1536x1152px; fundus photo: 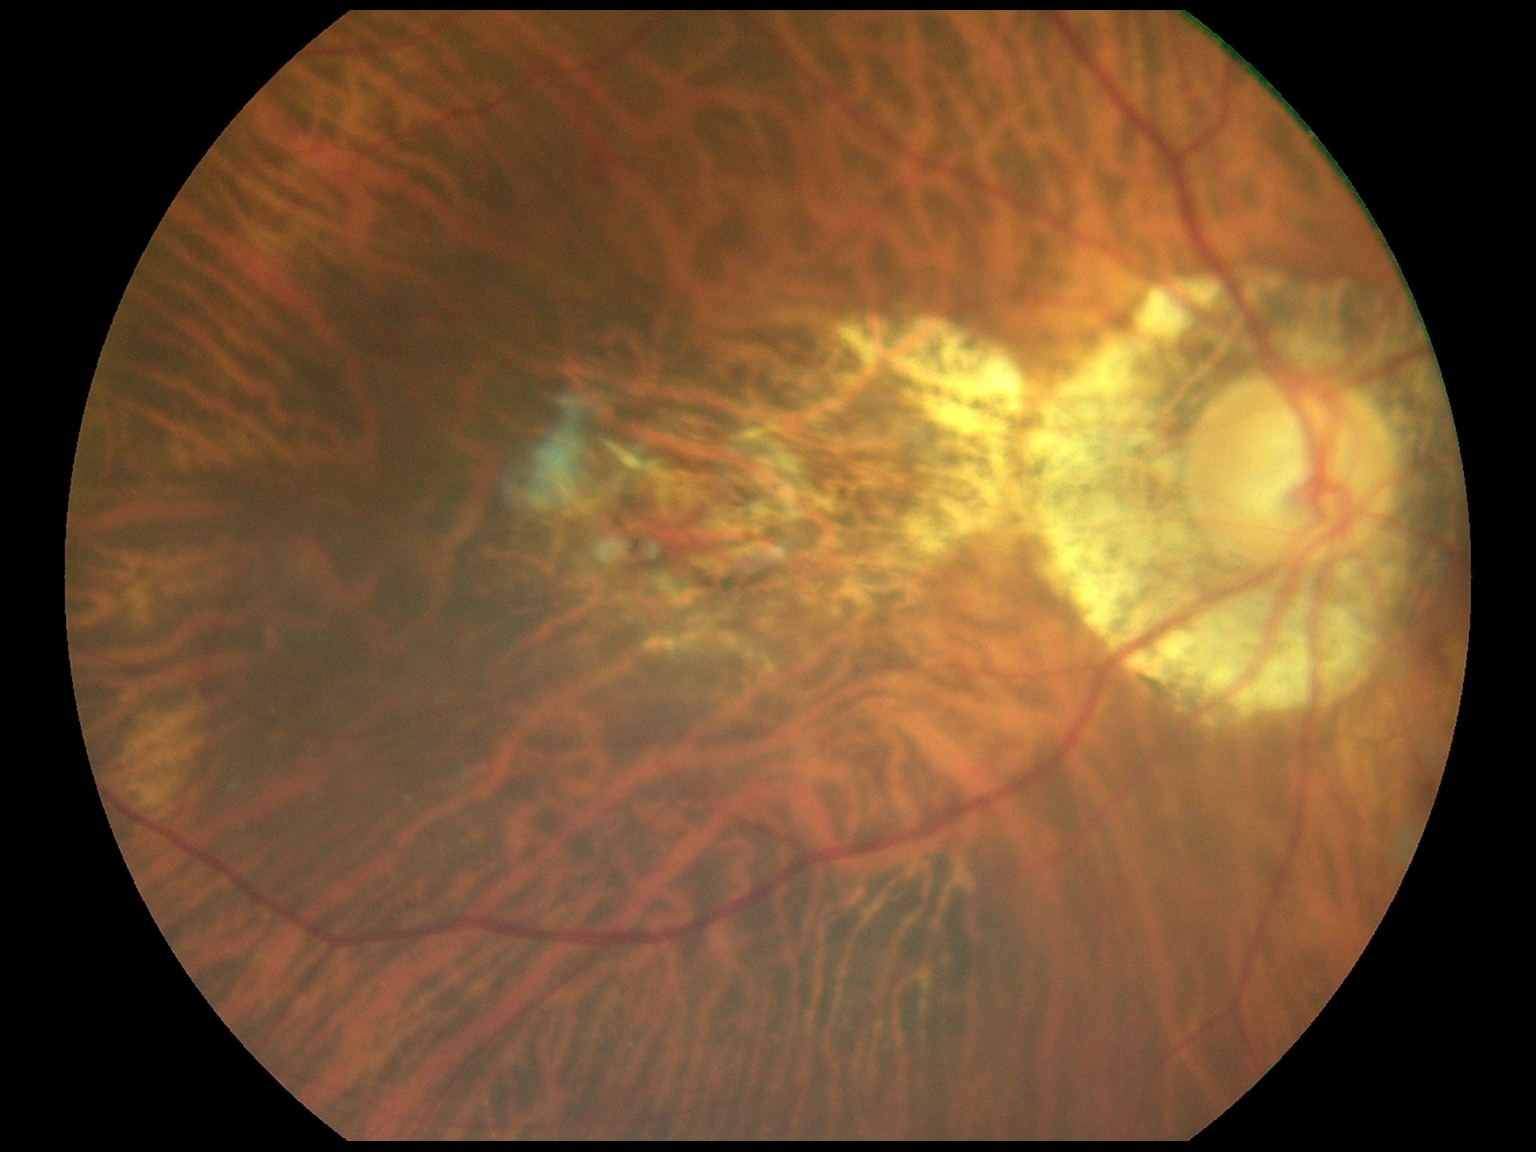
dr_grade: 2 — more than just microaneurysms but less than severe NPDR